Acquired on the Phoenix ICON · wide-field fundus photograph of an infant — 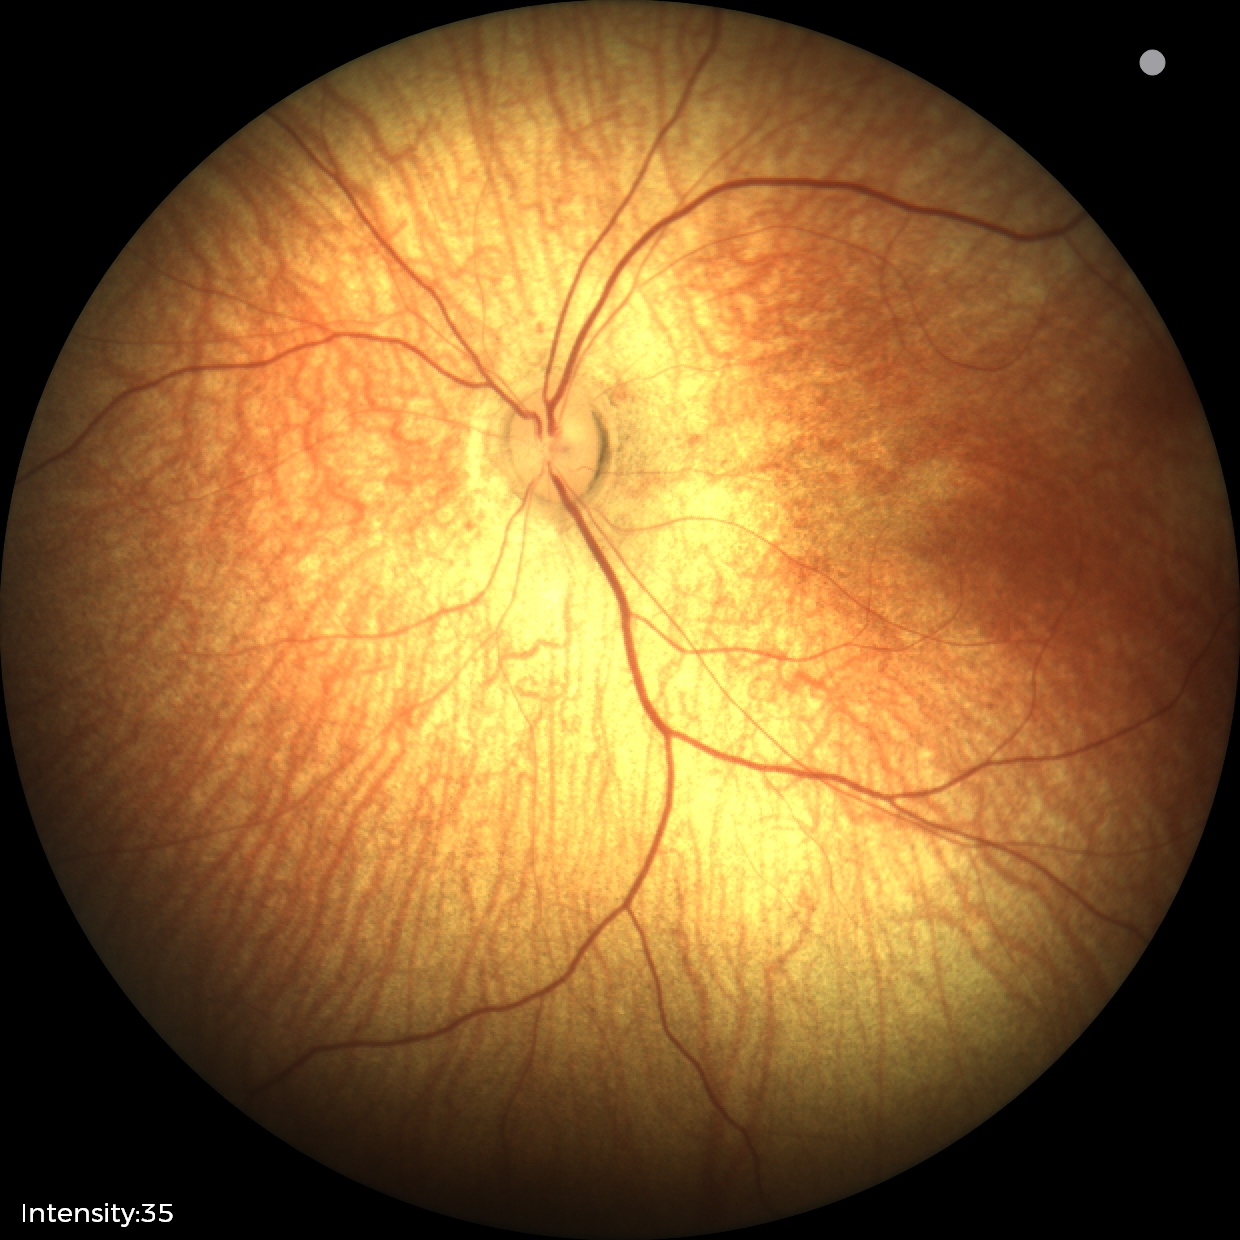 Screening: physiological finding.